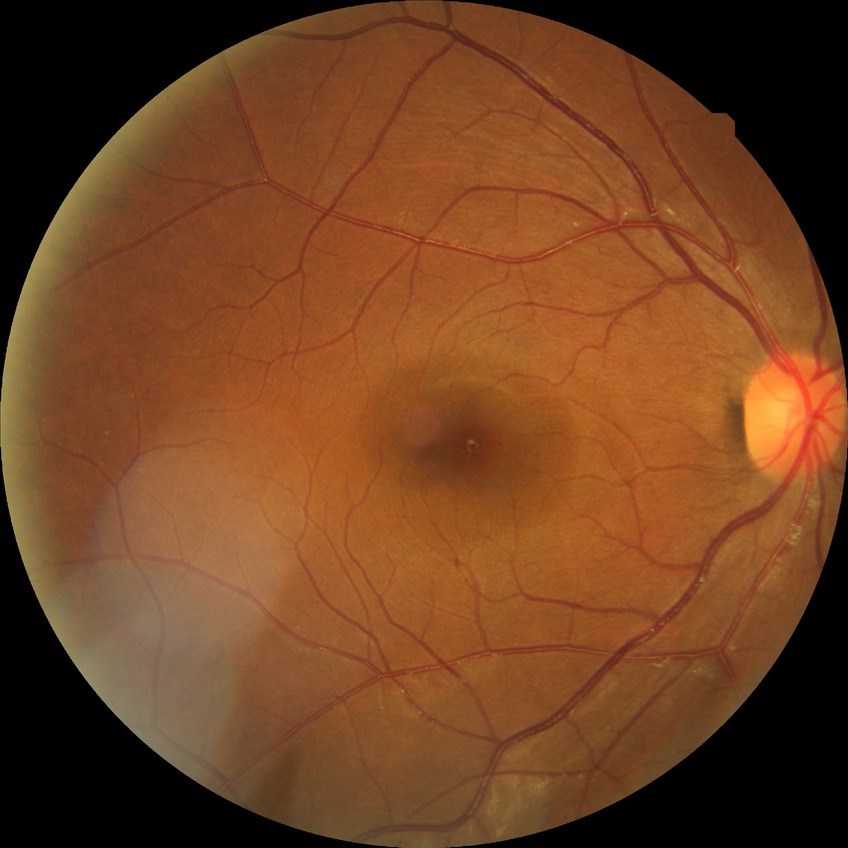 Diabetic retinopathy (DR) is no diabetic retinopathy (NDR).